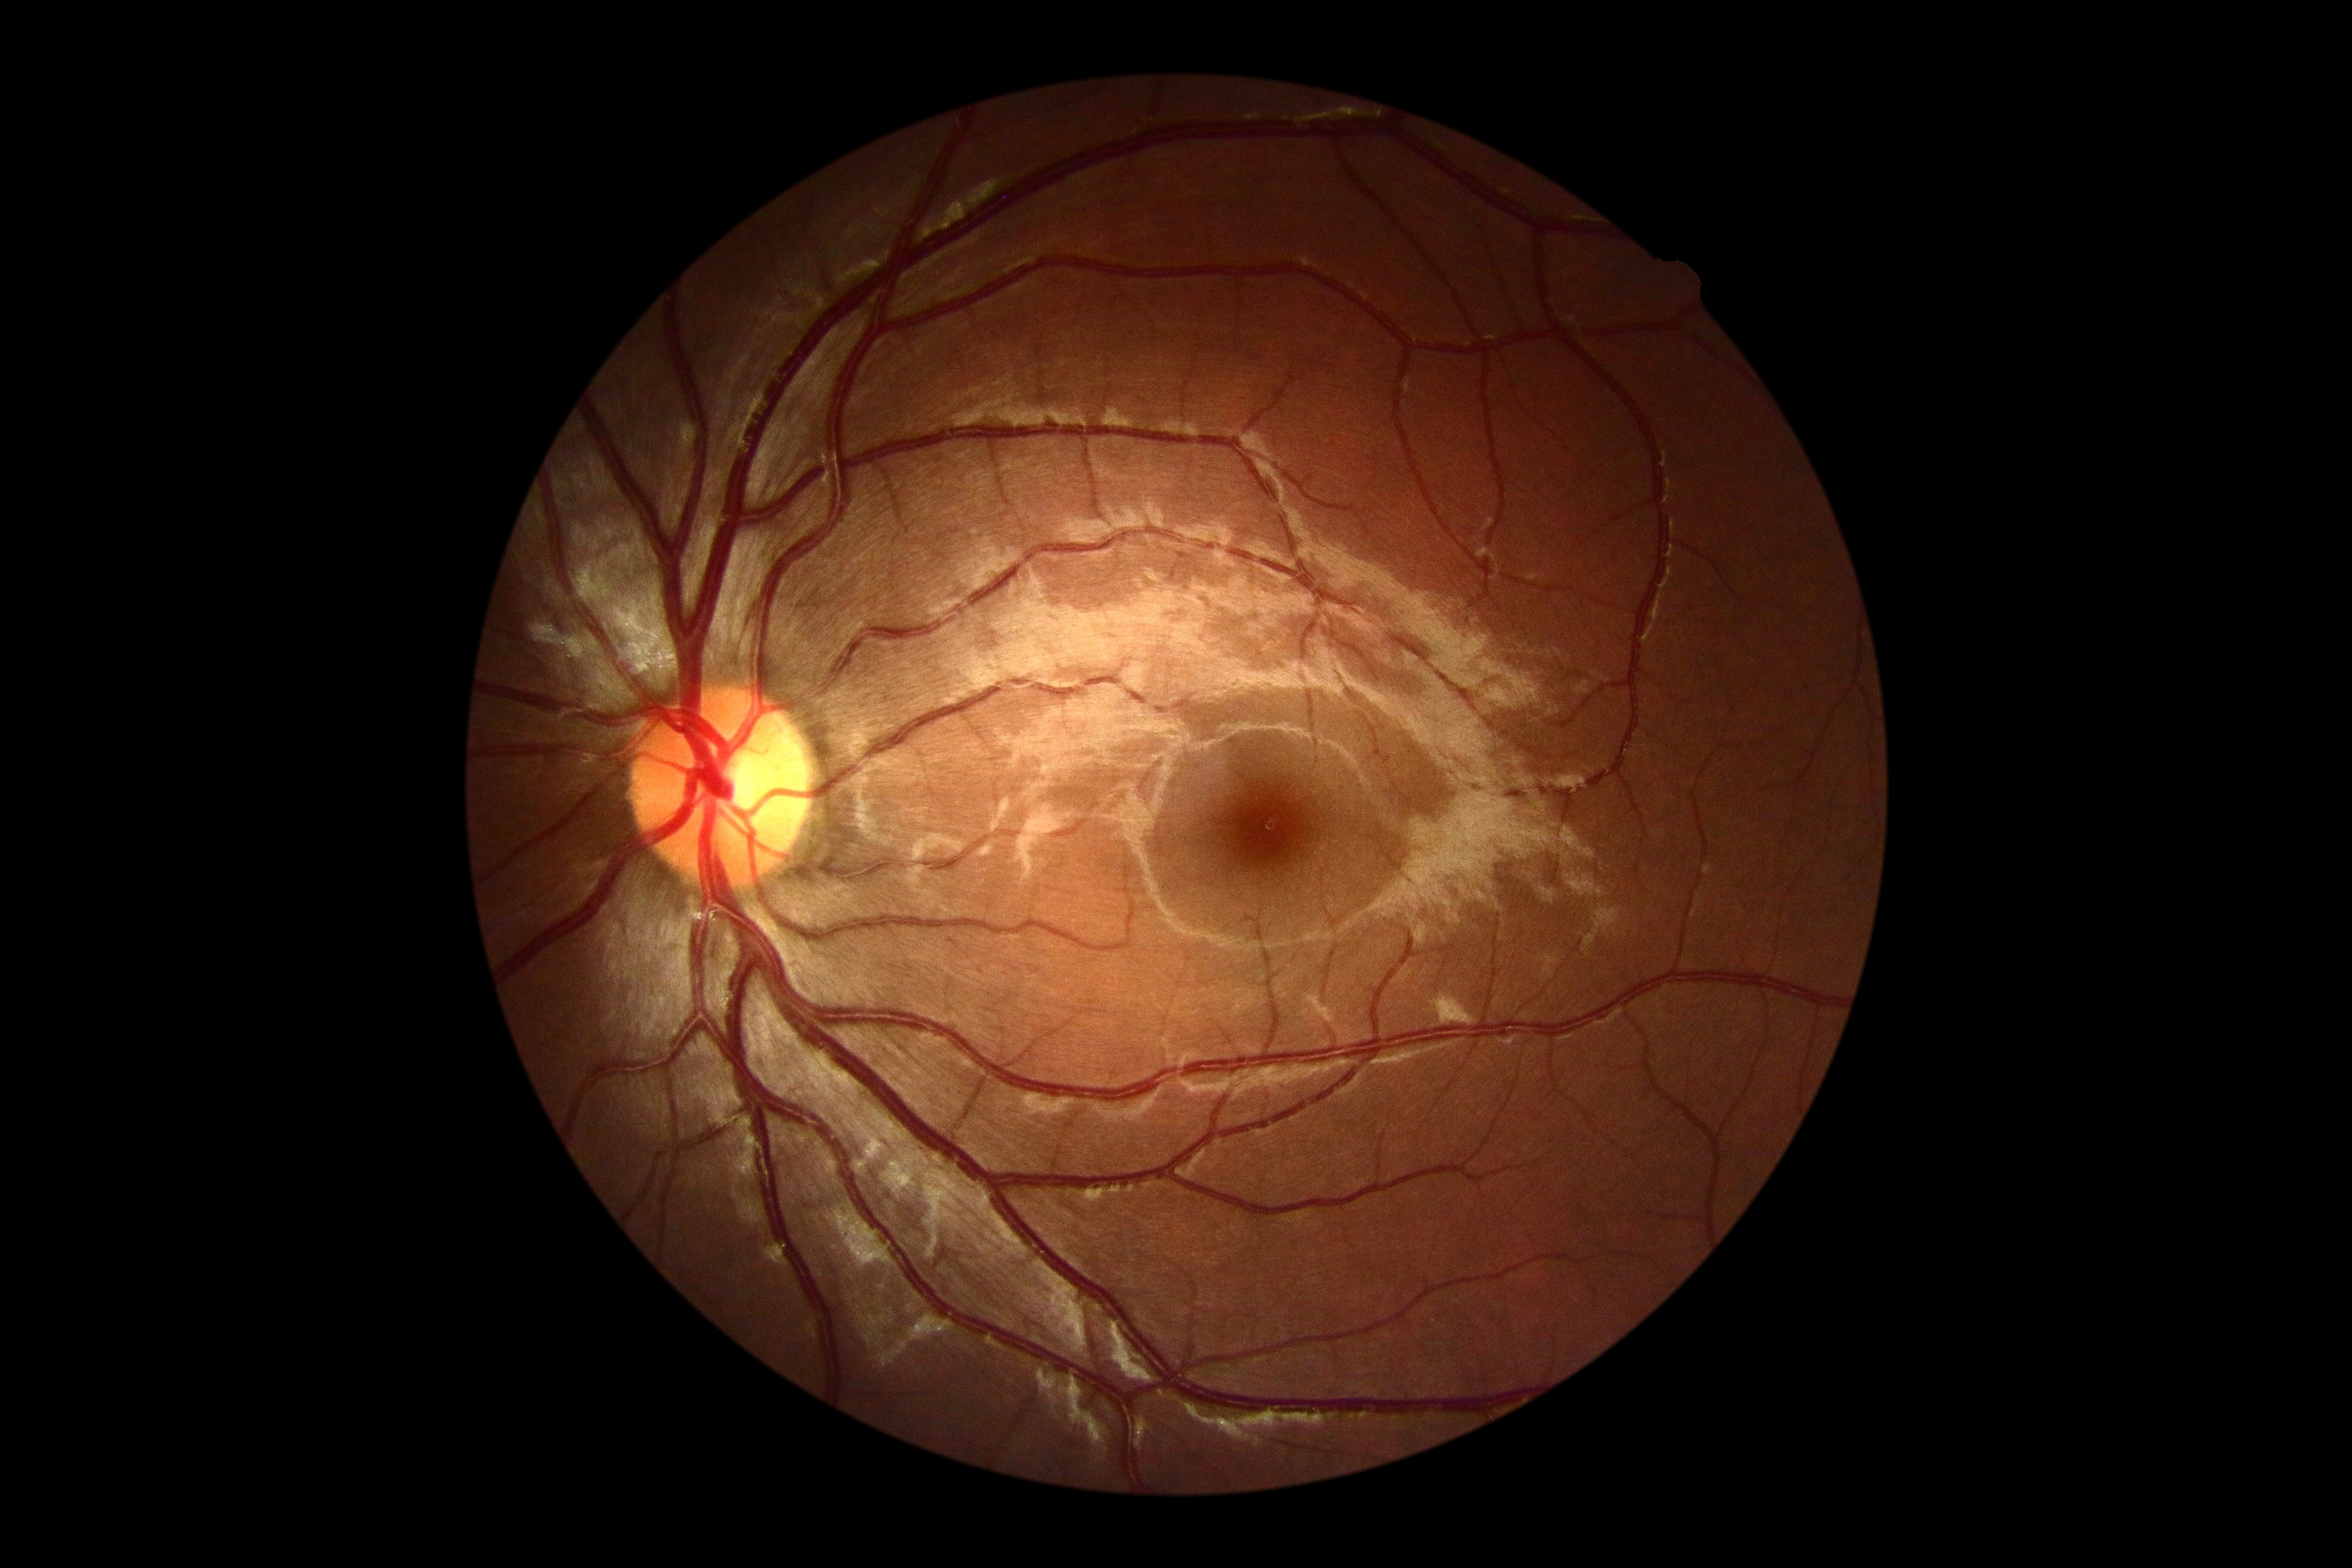
dr_grade: grade 0 (no apparent retinopathy) — no visible signs of diabetic retinopathy